CFP; 2212x1659px.
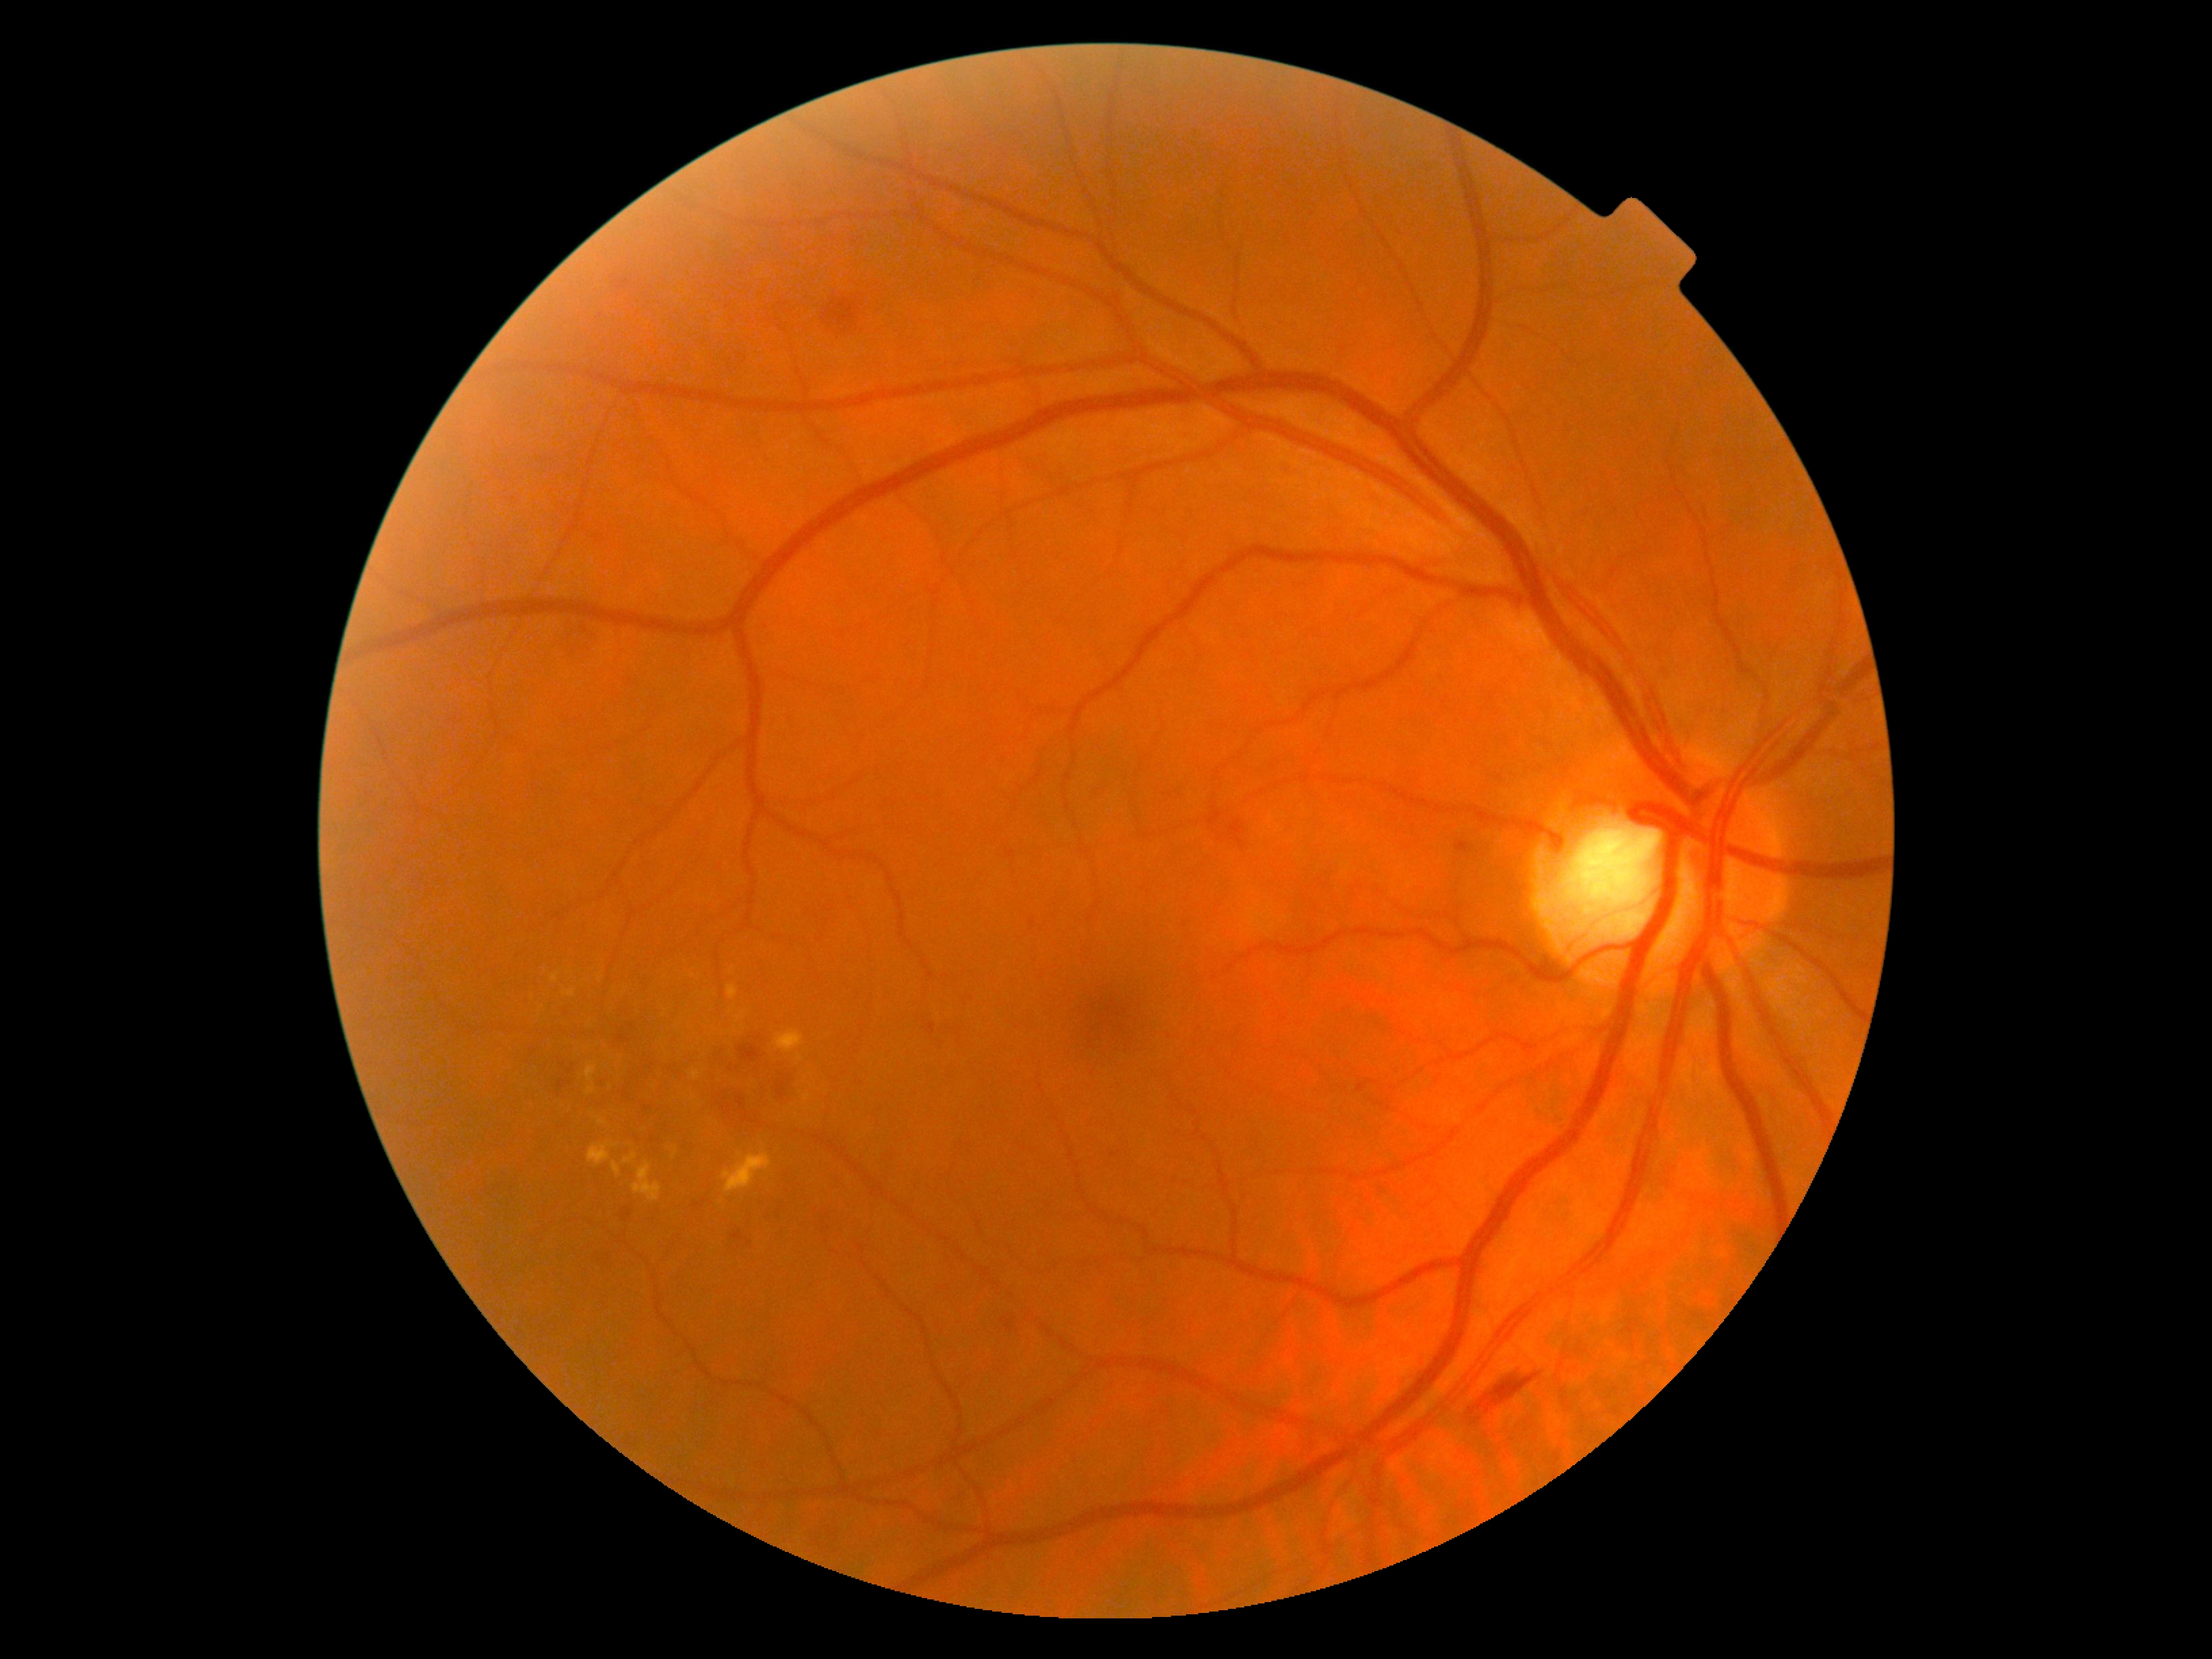
Diabetic retinopathy (DR) is moderate NPDR (grade 2).